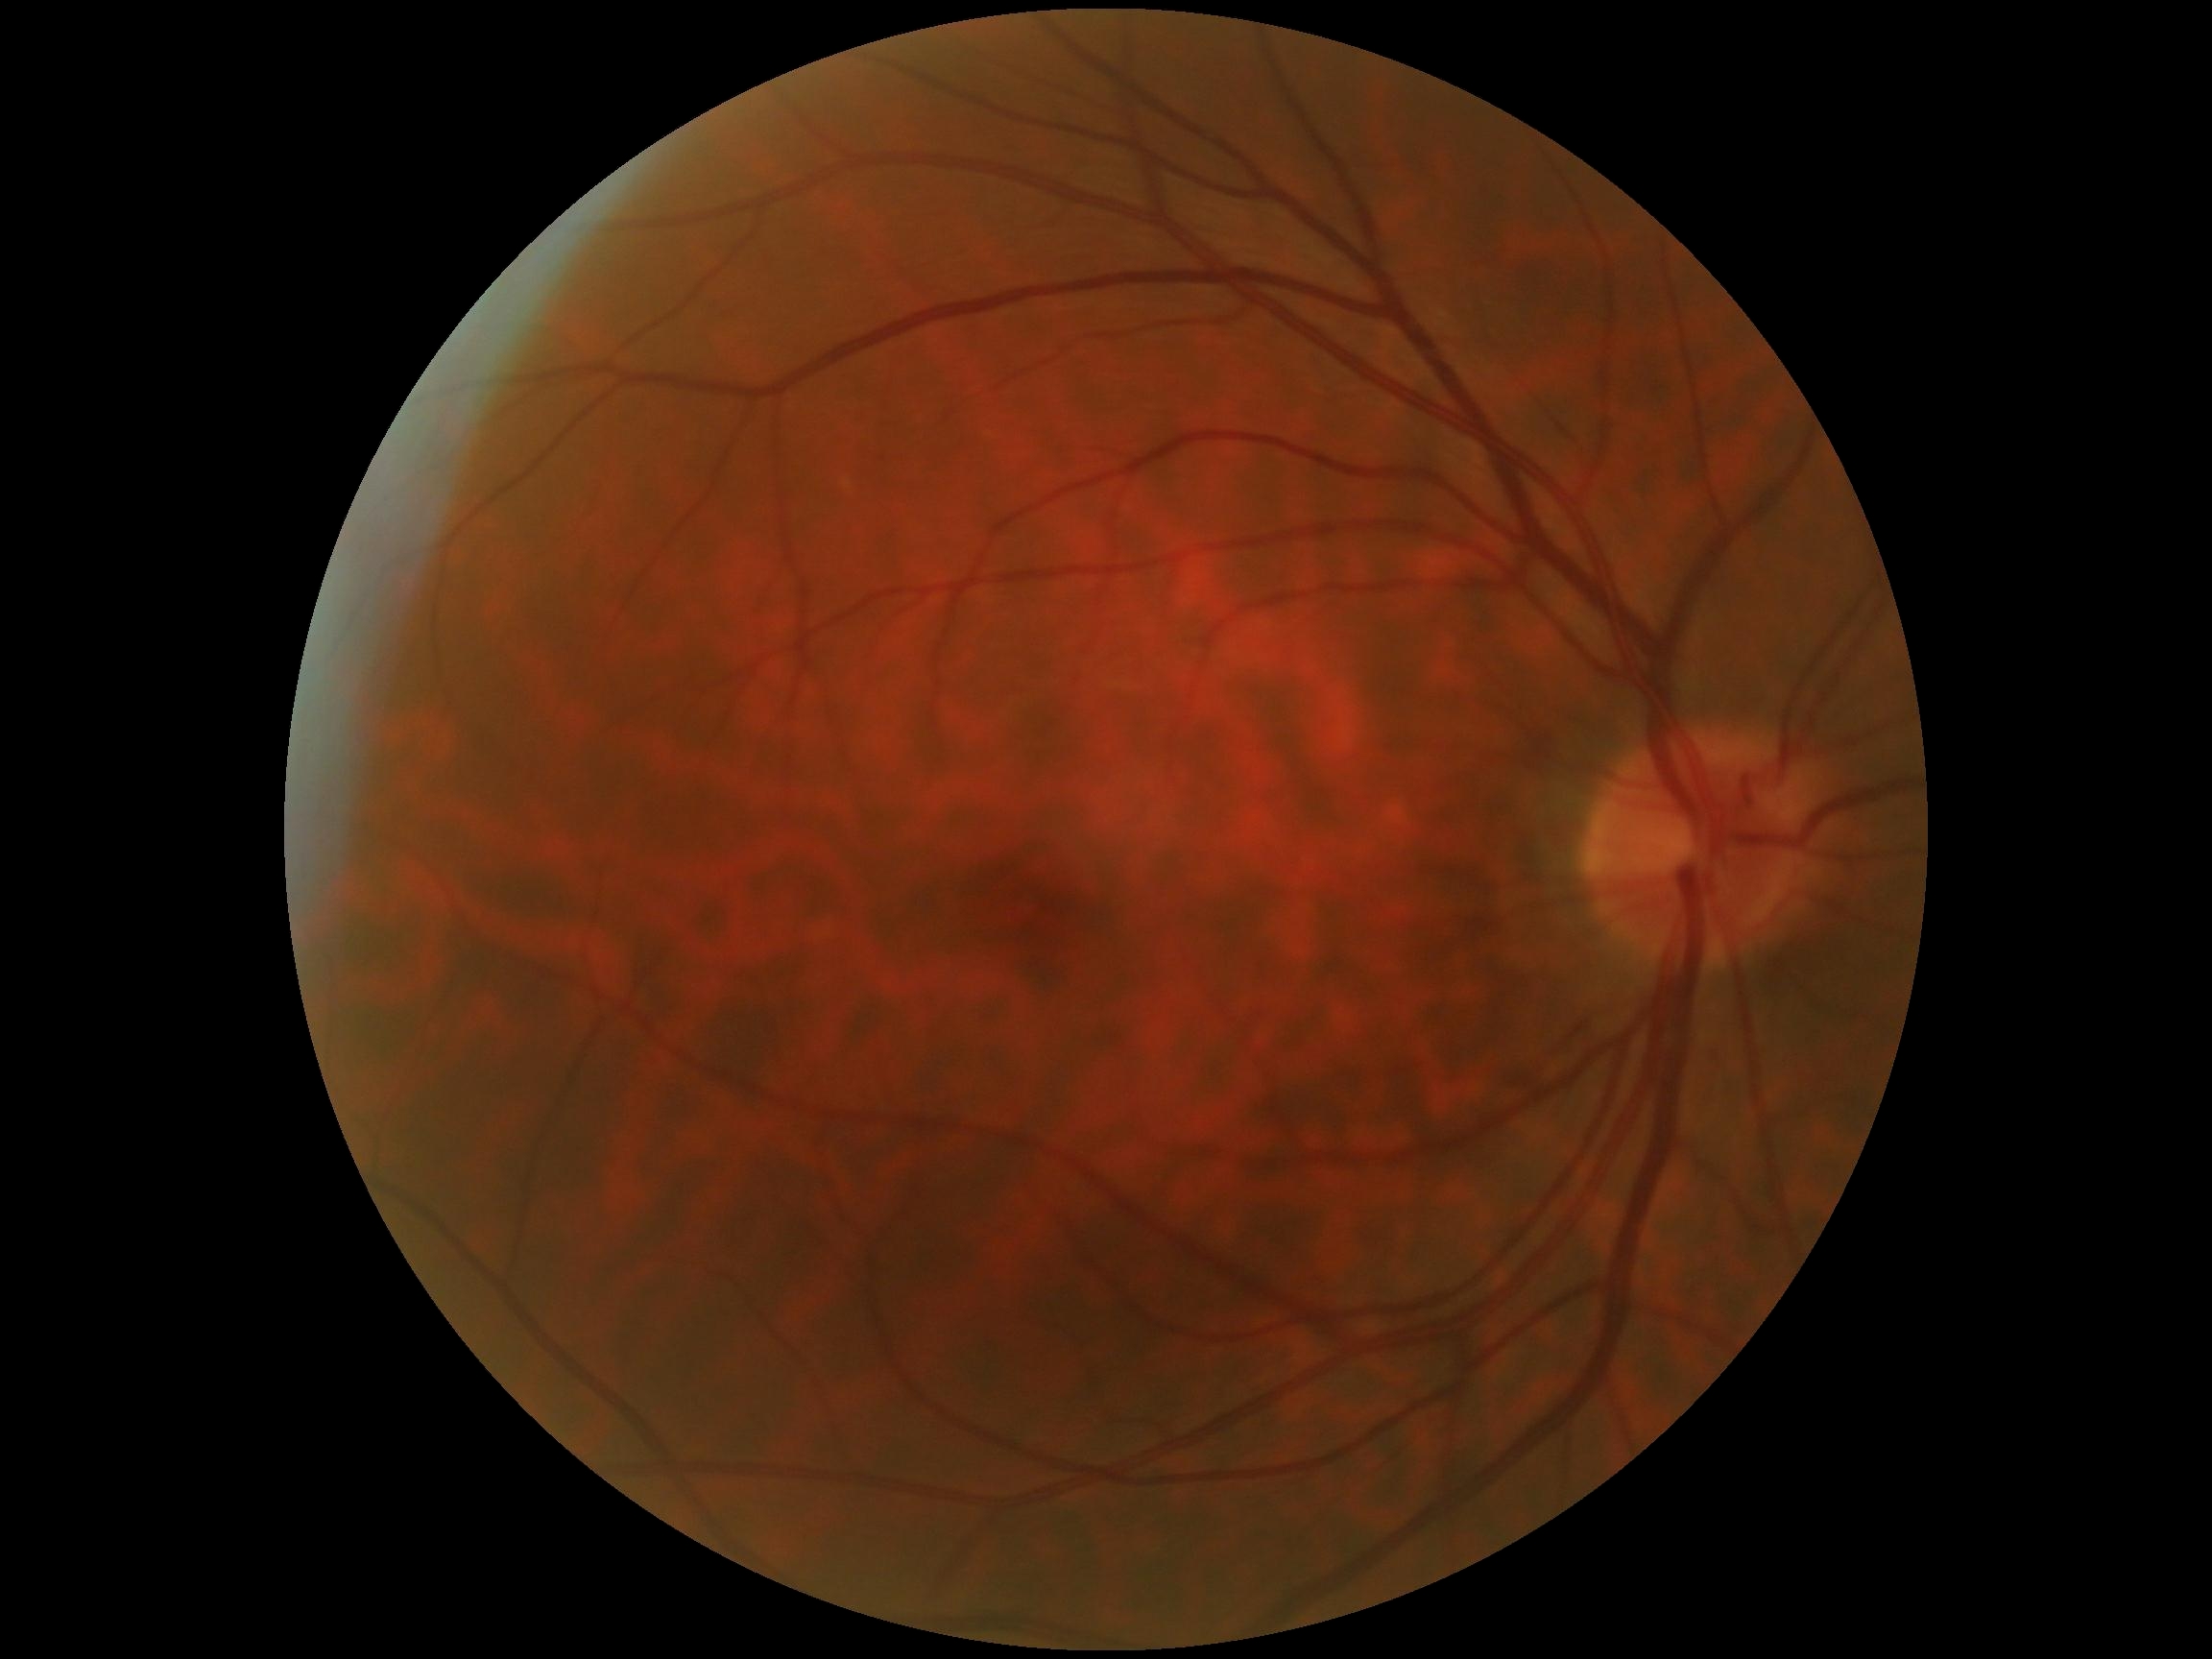

DR is 0/4 — no visible signs of diabetic retinopathy.